Fundus photo, 2352 x 1568 pixels, FOV: 45 degrees:
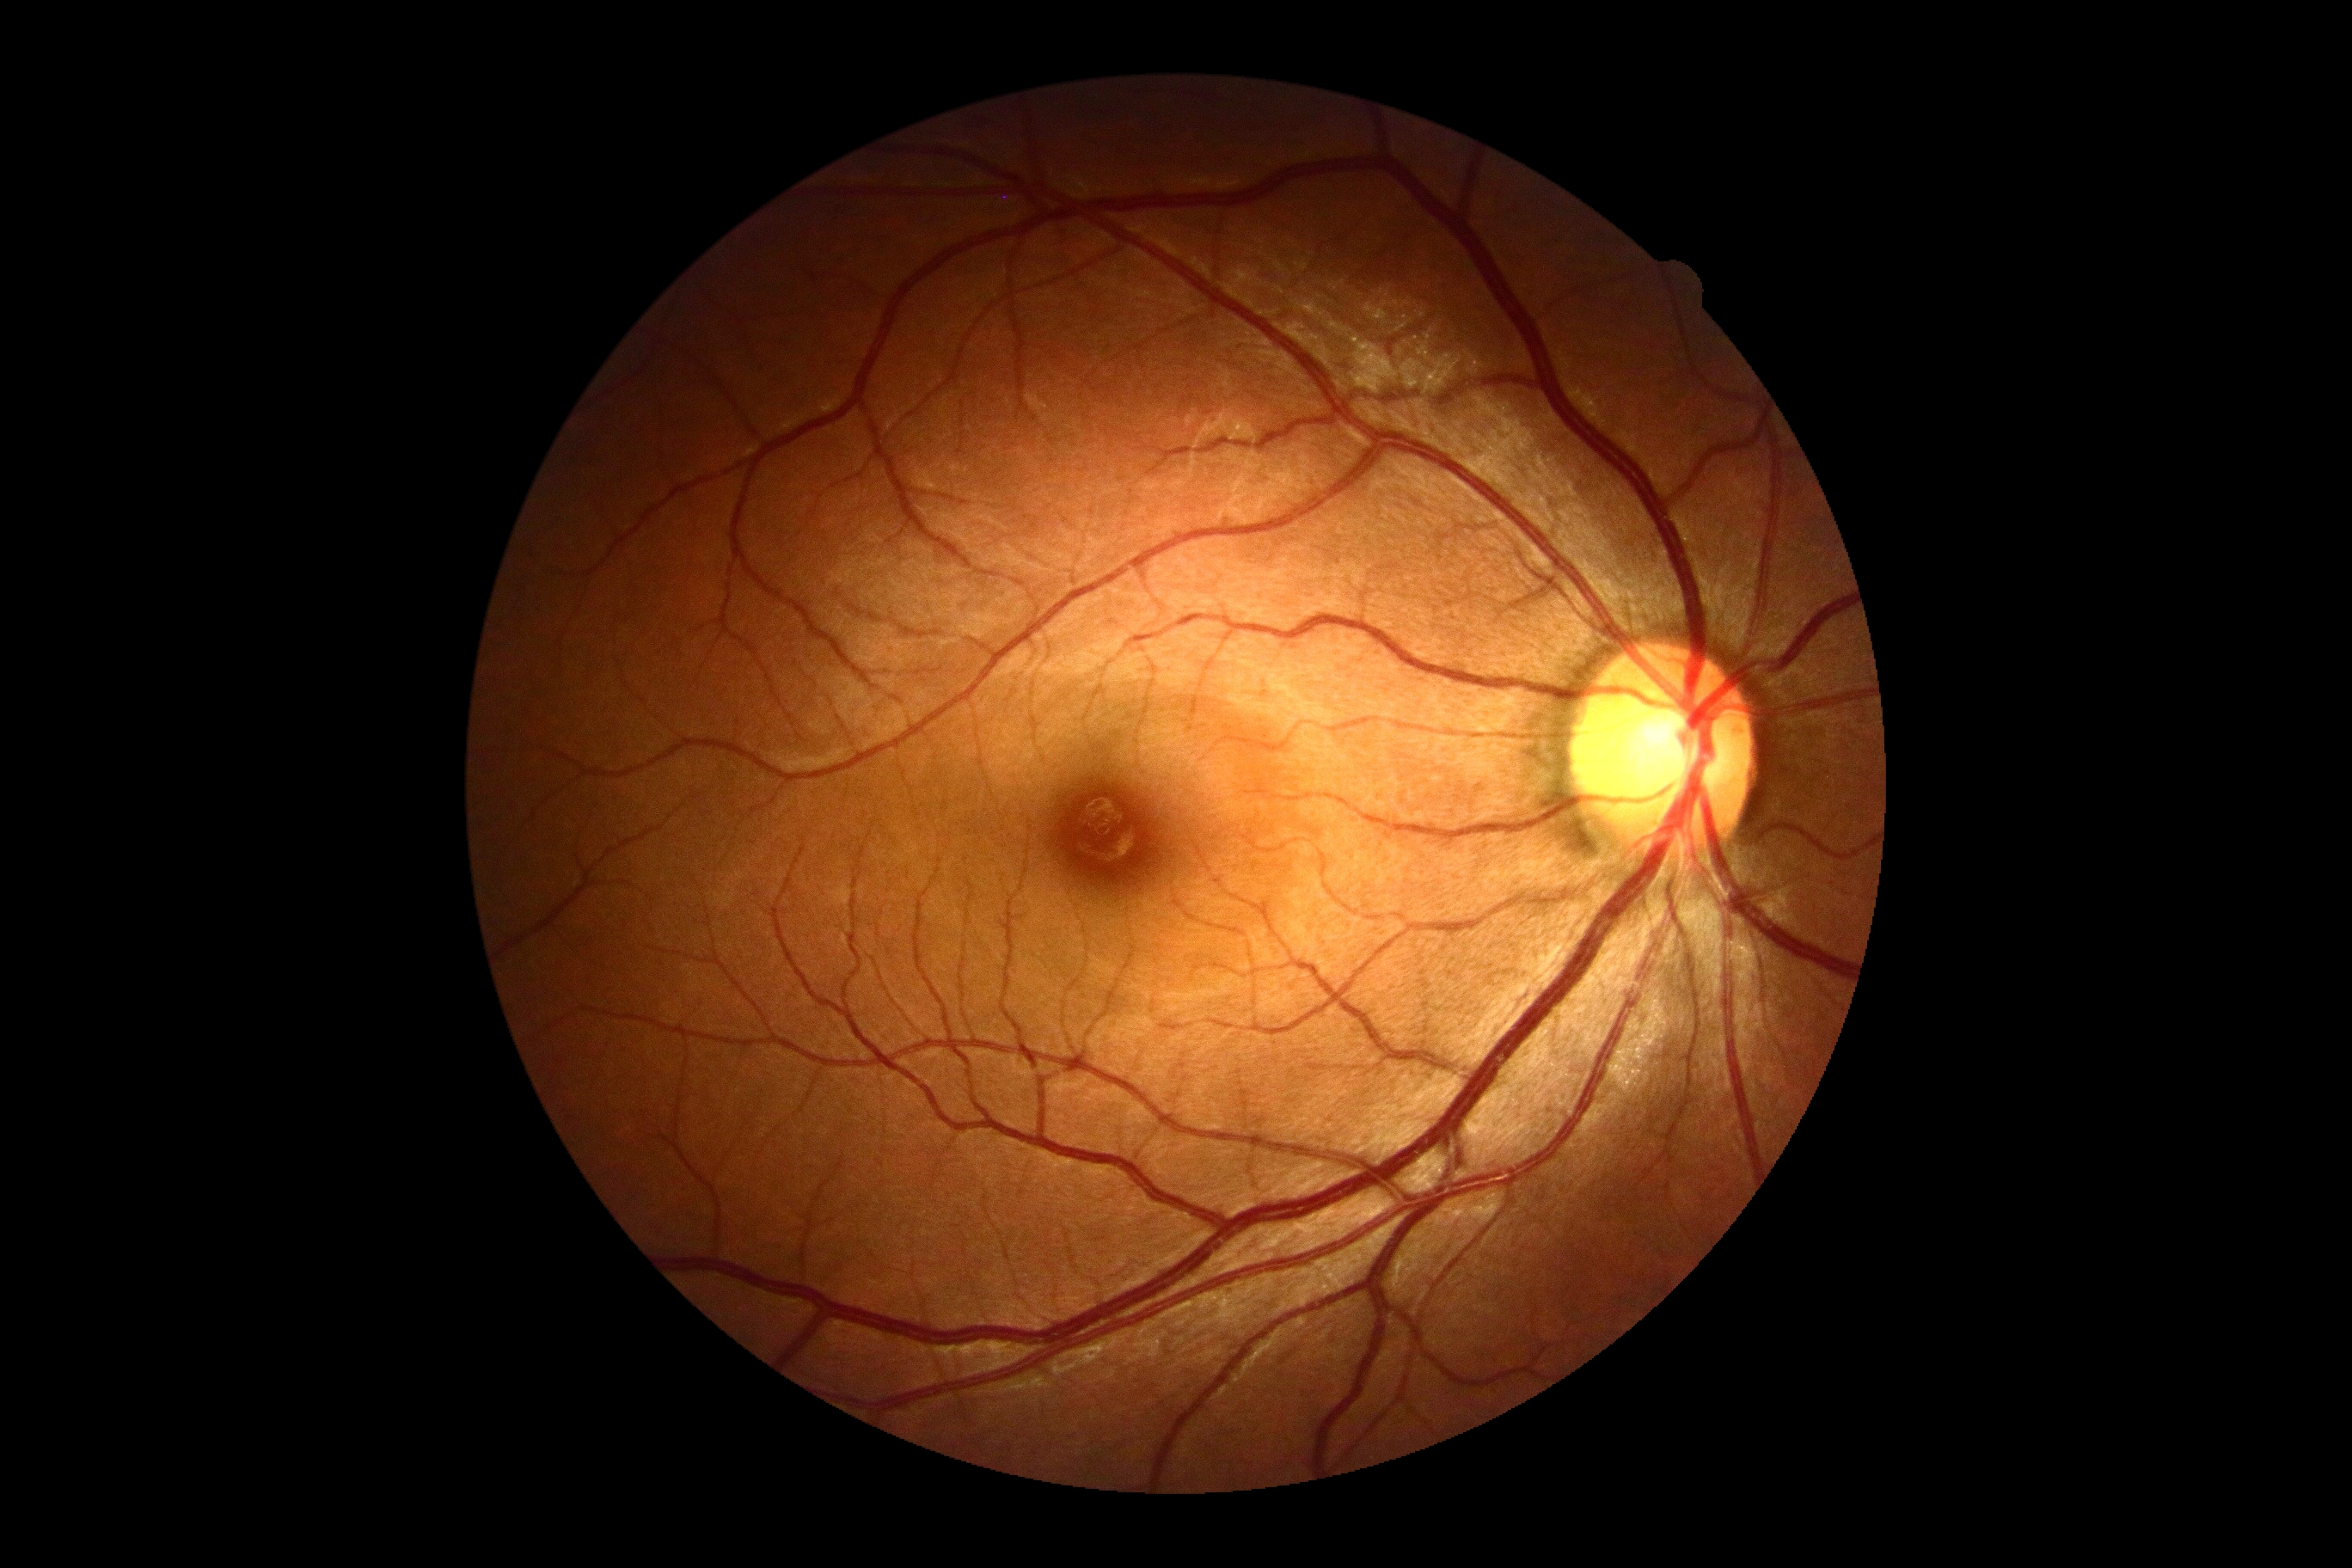 – DR severity — grade 0